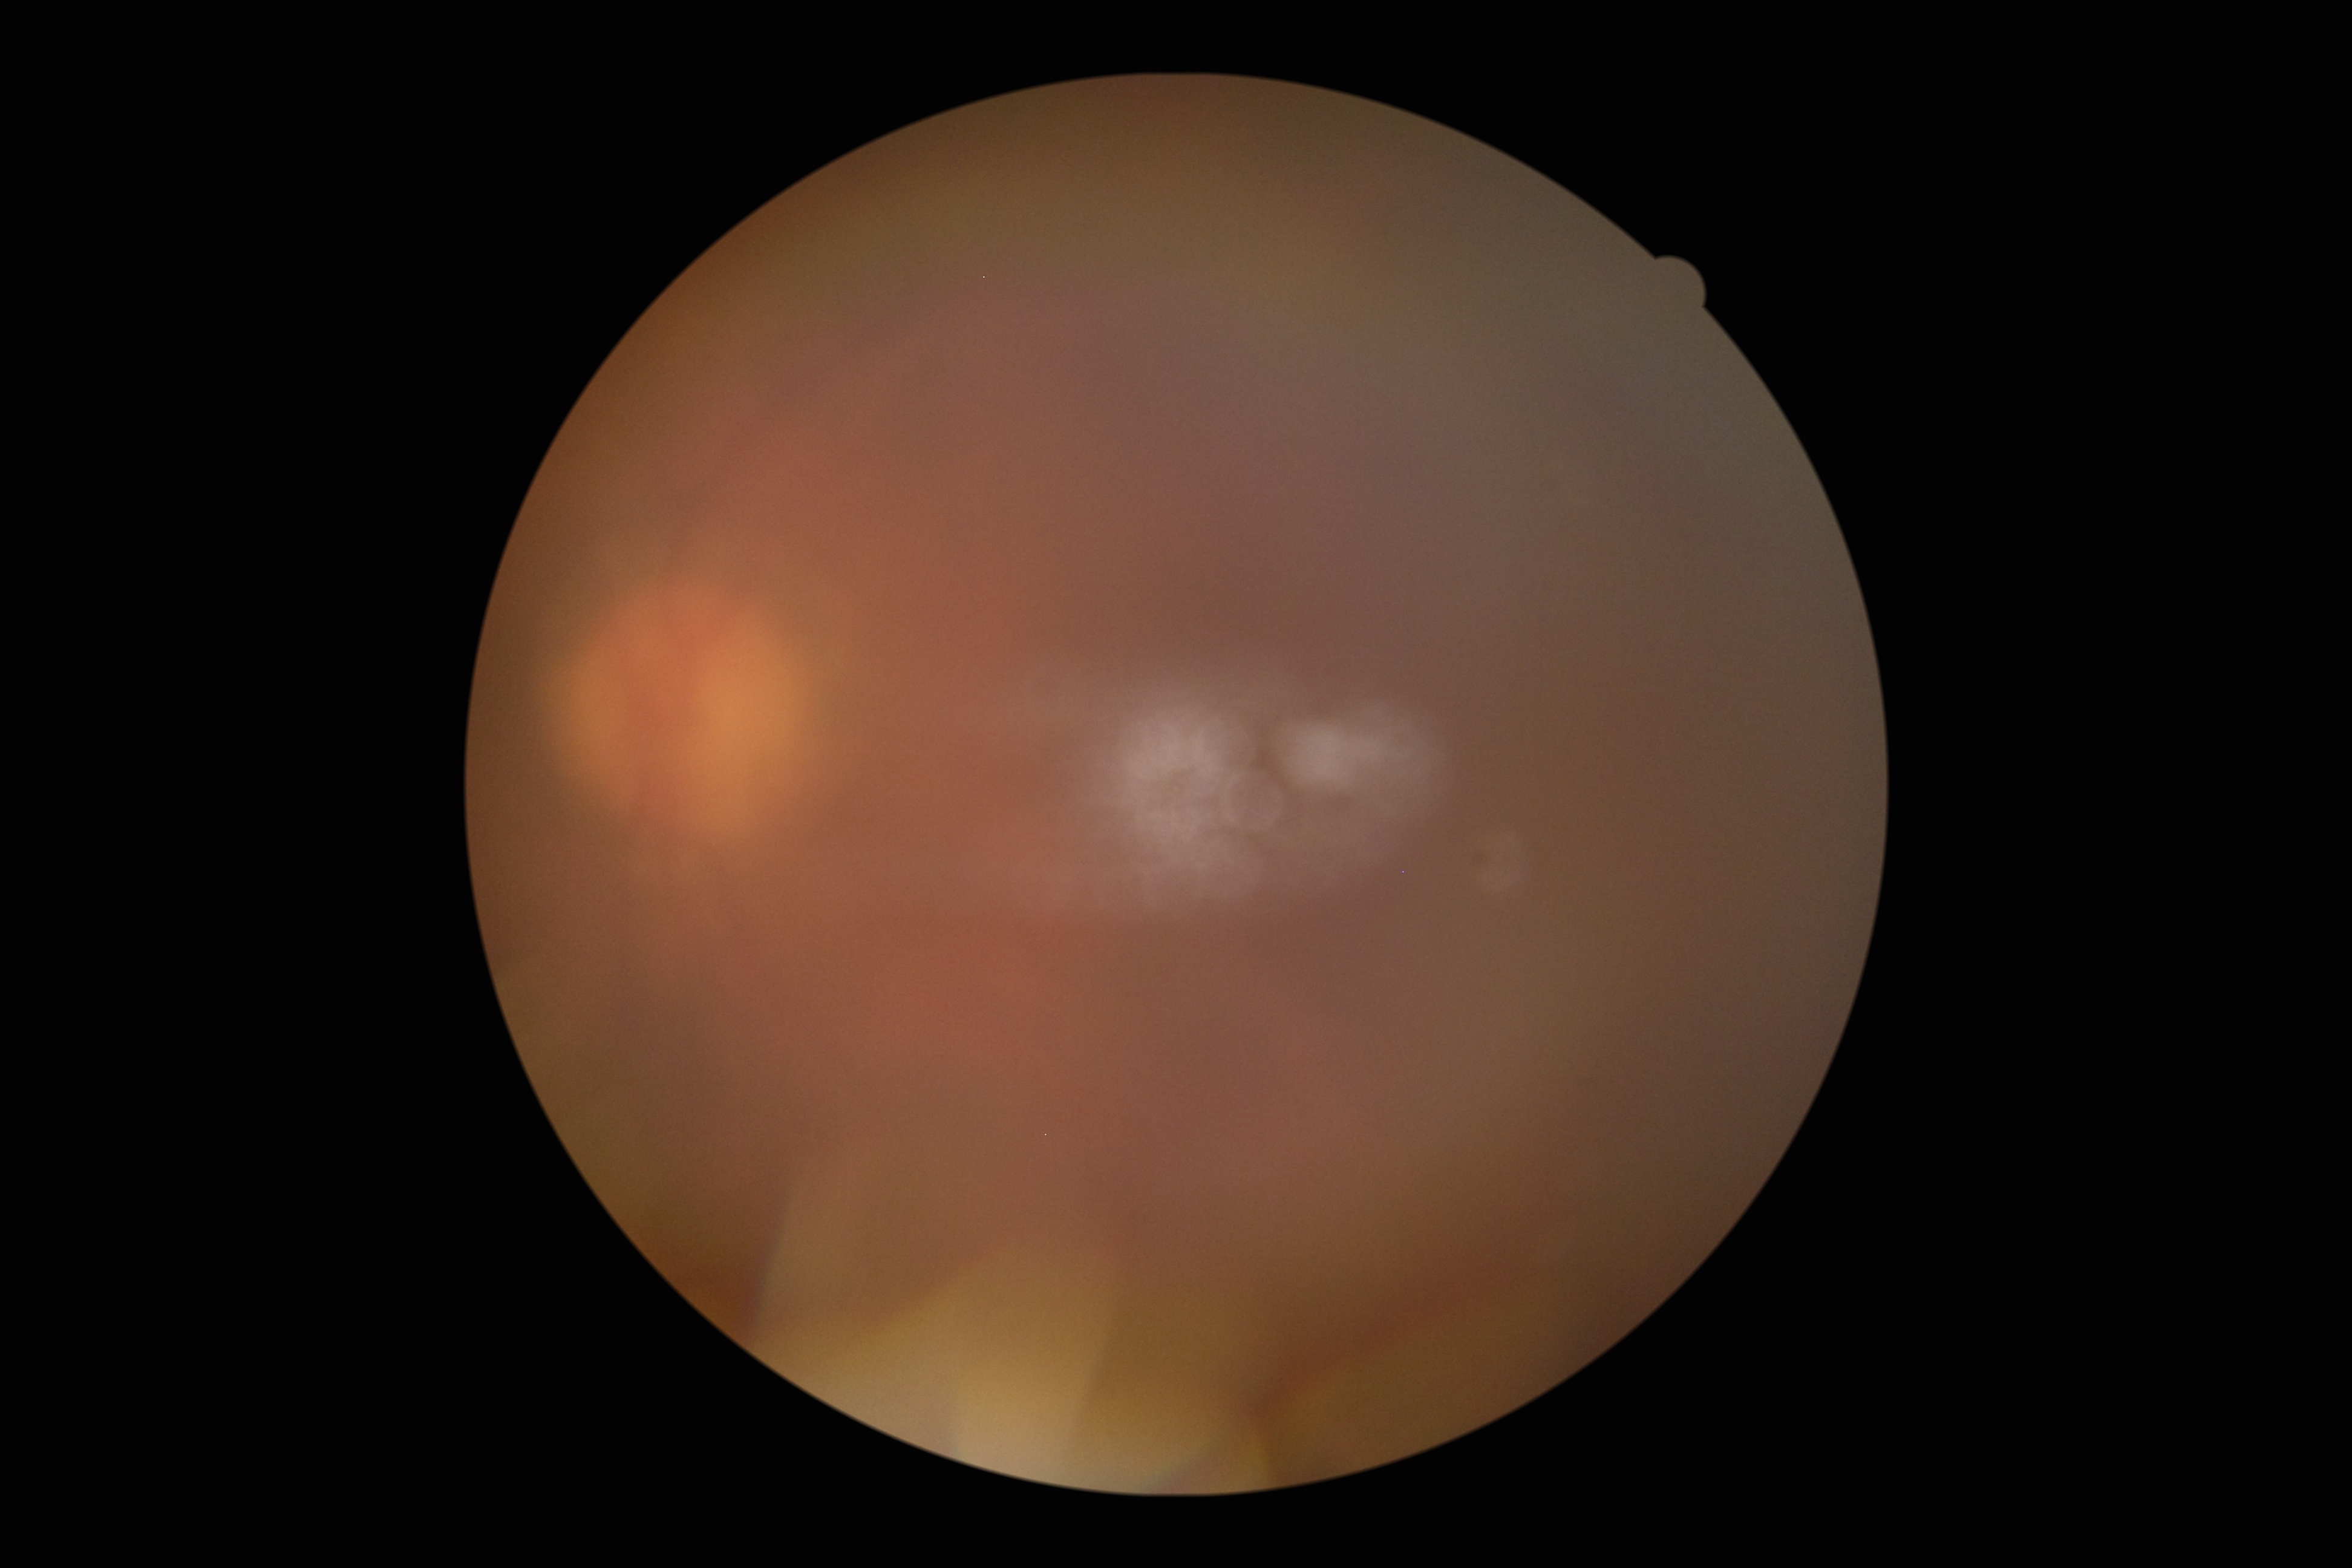 Ungradable image — DR severity cannot be determined. Diabetic retinopathy (DR) is ungradable.